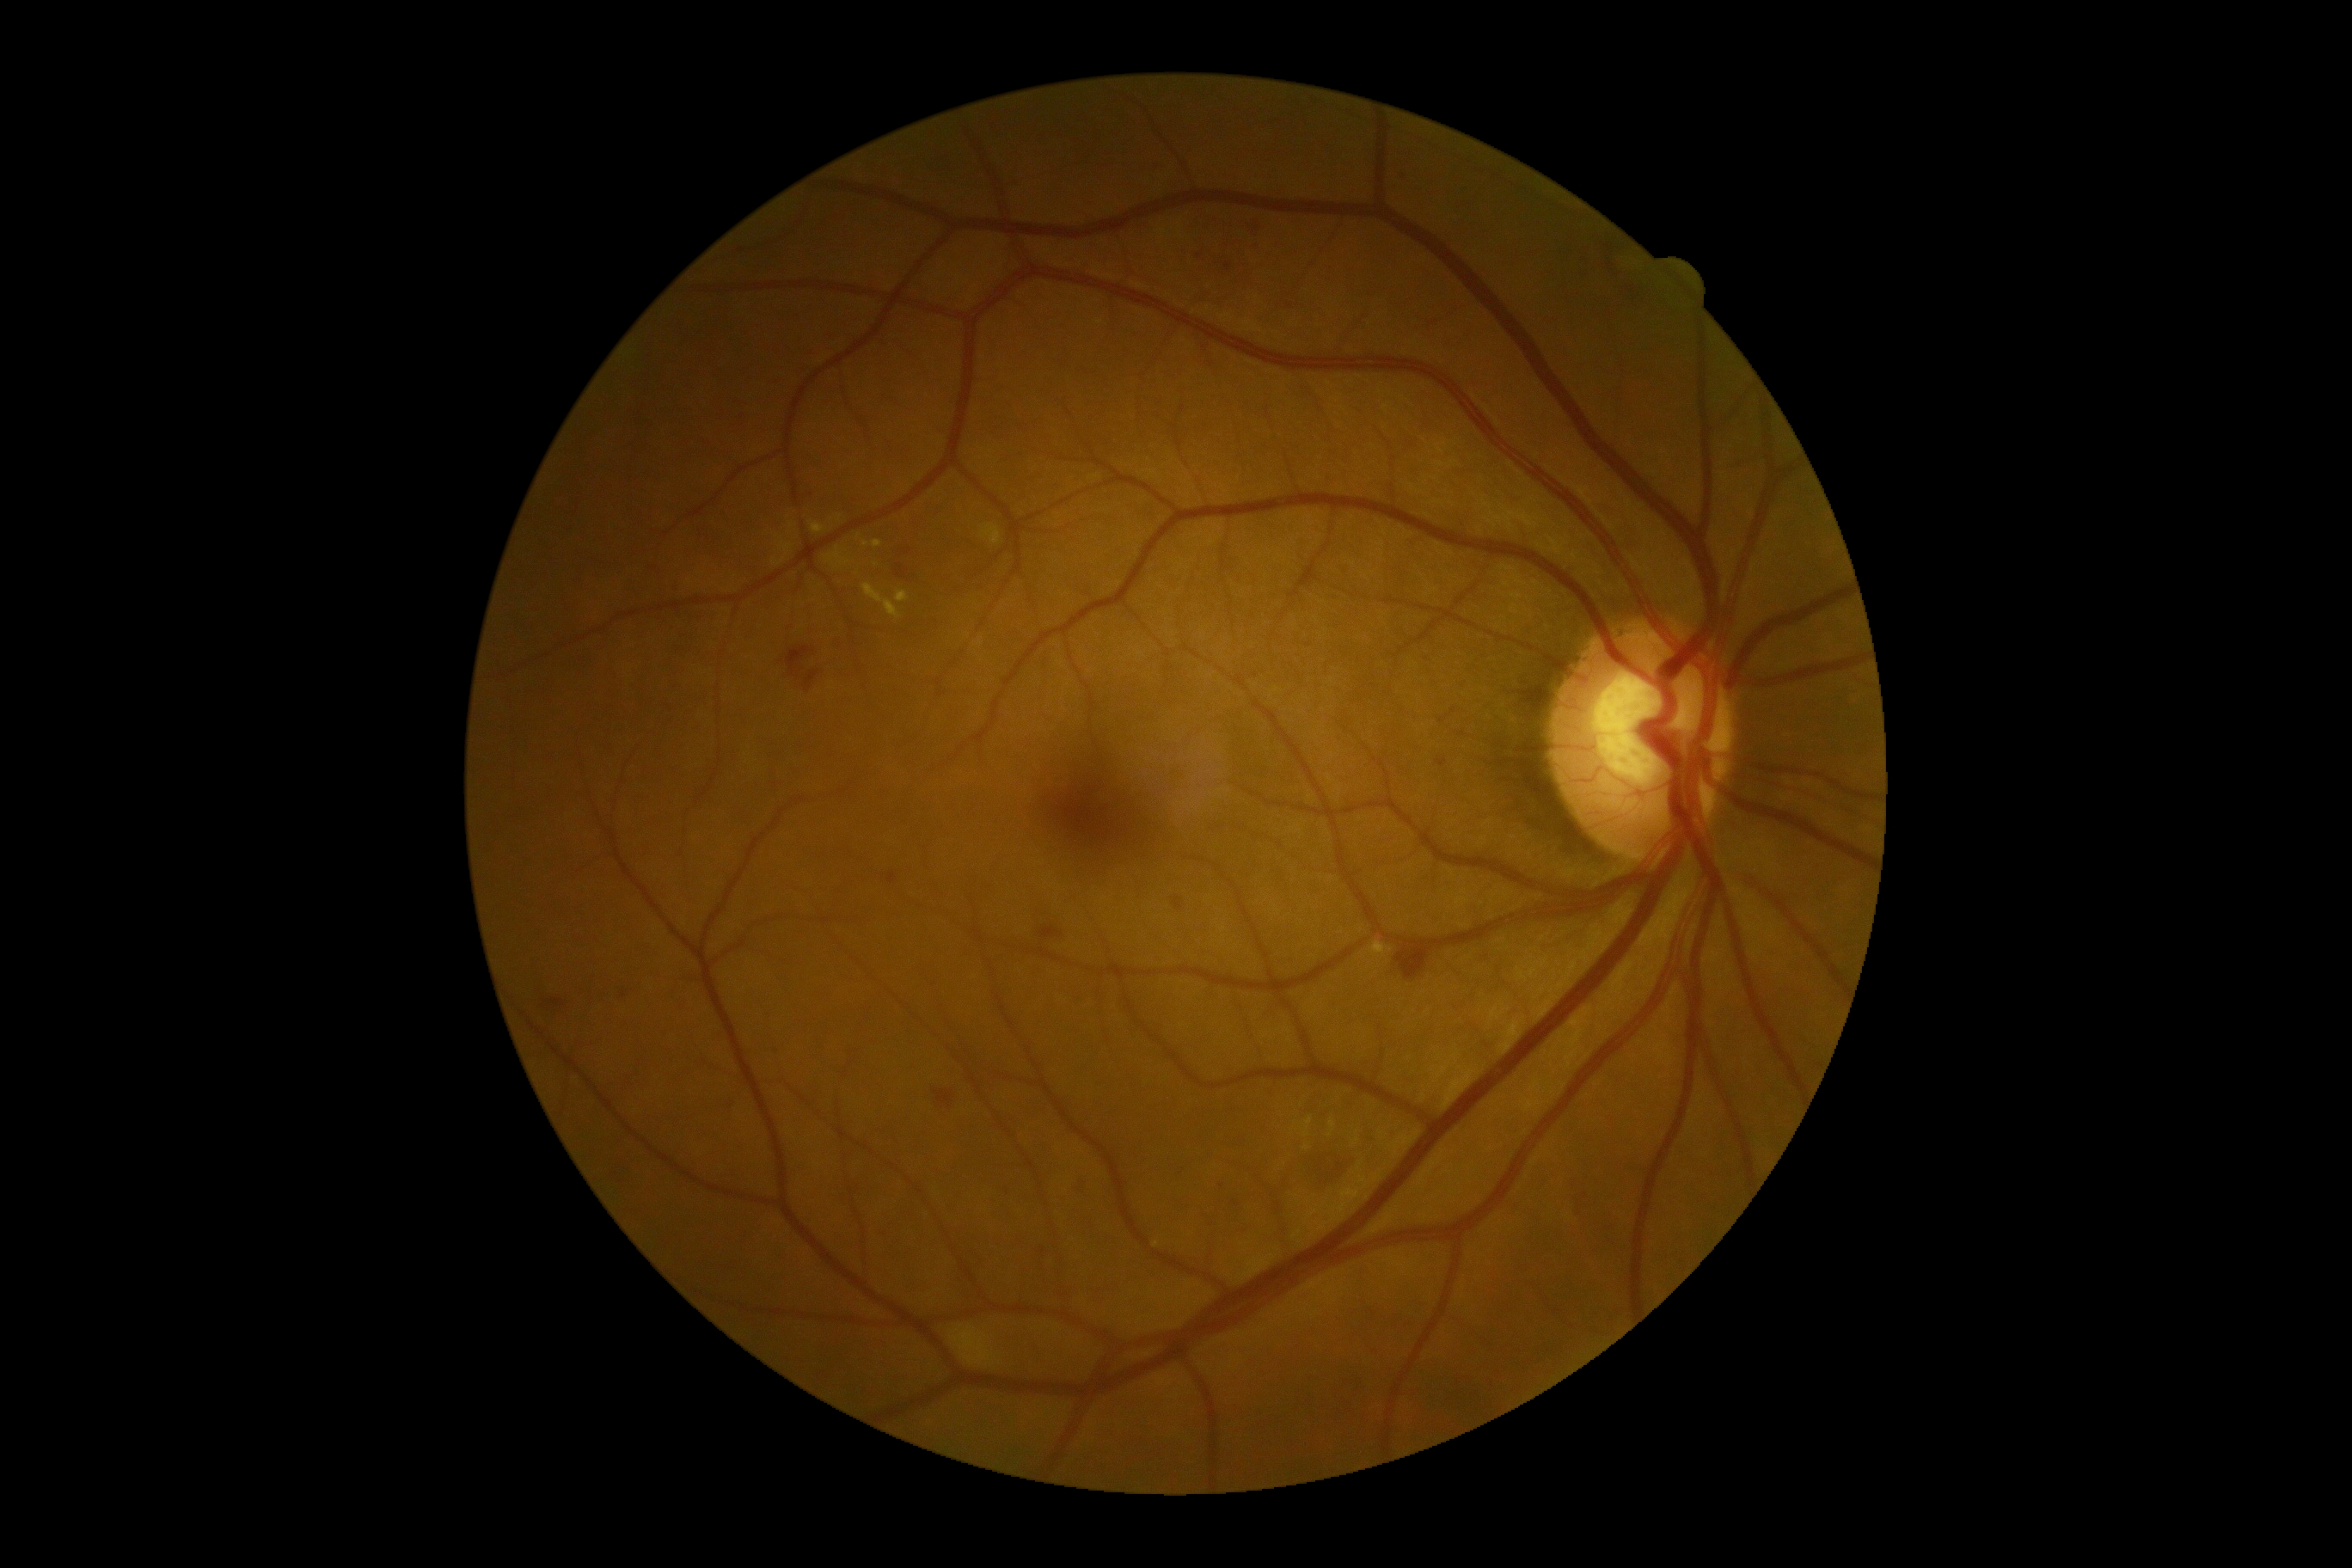
partial: true
dr_grade: 2
dr_grade_name: moderate NPDR
lesions:
  he:
    - (1299,1148,1352,1192)
    - (805,671,819,689)
    - (1608,238,1651,307)
    - (1039,928,1063,940)
    - (934,1091,953,1105)
    - (1397,945,1430,984)
    - (1249,223,1259,250)
    - (897,565,907,579)
    - (898,548,914,558)
    - (787,647,812,678)
    - (546,995,570,1020)
  se:
    - (950,1326,995,1368)
  ma:
    - (1436,759,1449,768)
    - (888,873,898,885)
    - (1173,897,1184,910)
    - (1399,175,1409,181)
  ma_small_centers:
    - x=1227, y=267
    - x=1442, y=722
    - x=1453, y=711
    - x=1199, y=257
  ex:
    - (1371,941,1393,957)
    - (1301,1117,1314,1137)
    - (1328,1120,1337,1137)
    - (981,524,1001,546)
    - (862,584,902,620)
    - (895,591,909,603)
    - (773,556,787,567)
    - (826,548,852,570)
    - (873,541,883,548)
    - (811,522,826,534)
    - (780,542,793,553)
  ex_small_centers:
    - x=840, y=517
    - x=791, y=526
    - x=867, y=545
    - x=859, y=538
    - x=1306, y=1148
    - x=779, y=538